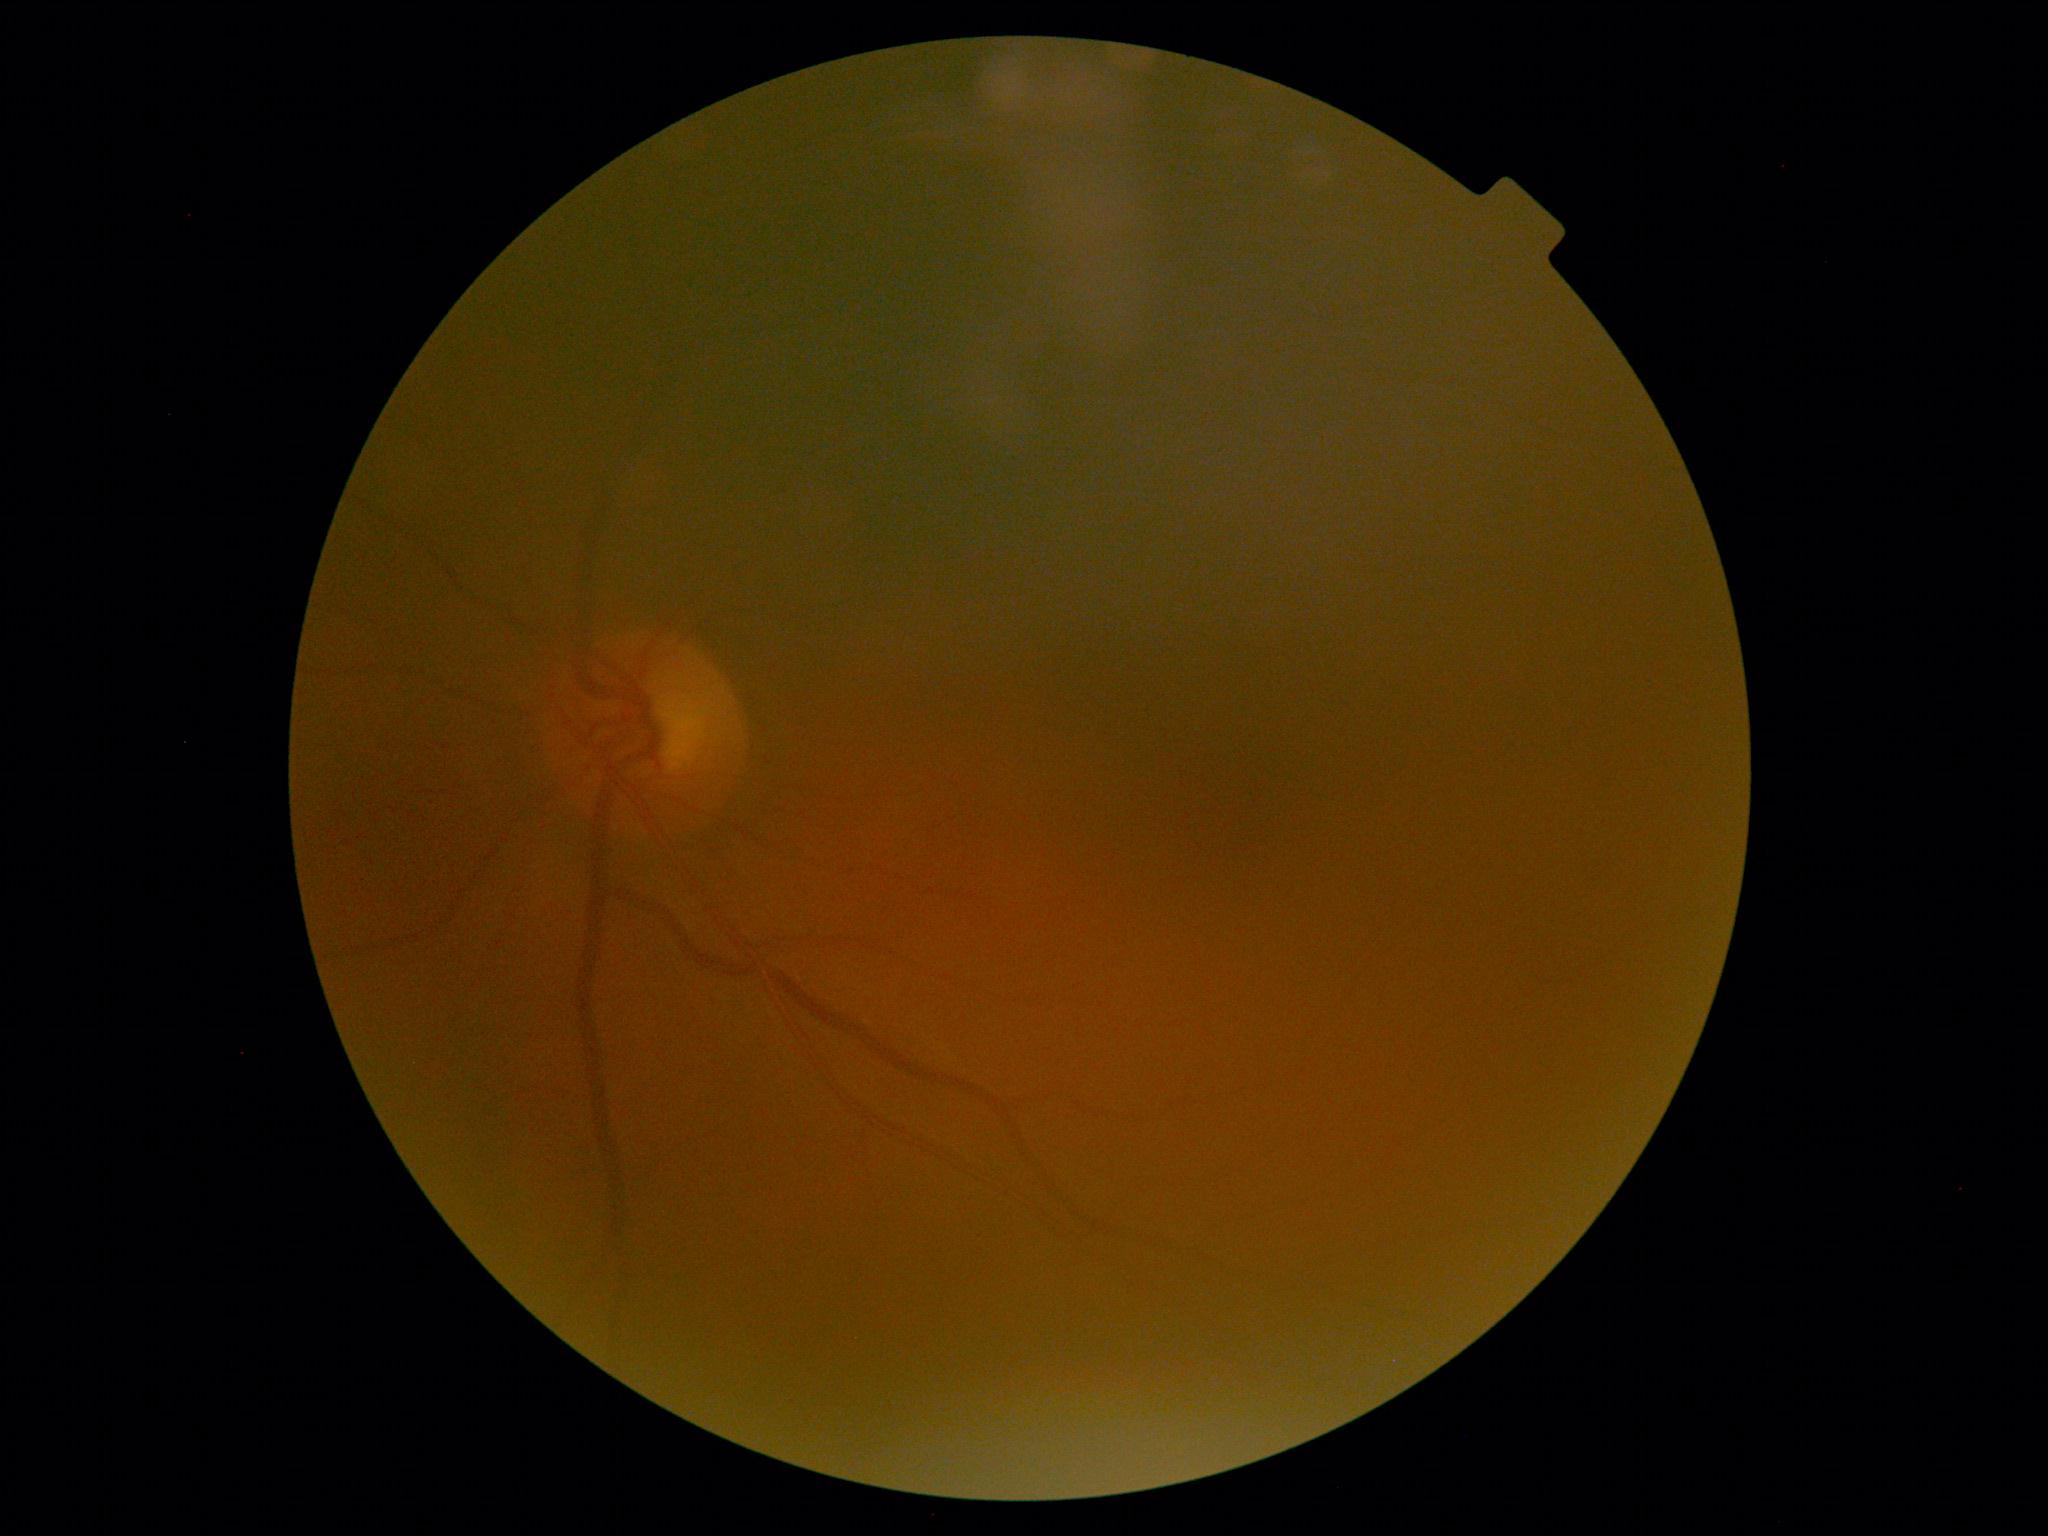
Diabetic retinopathy: no apparent retinopathy (grade 0).